Diabetic retinopathy graded by the modified Davis classification: 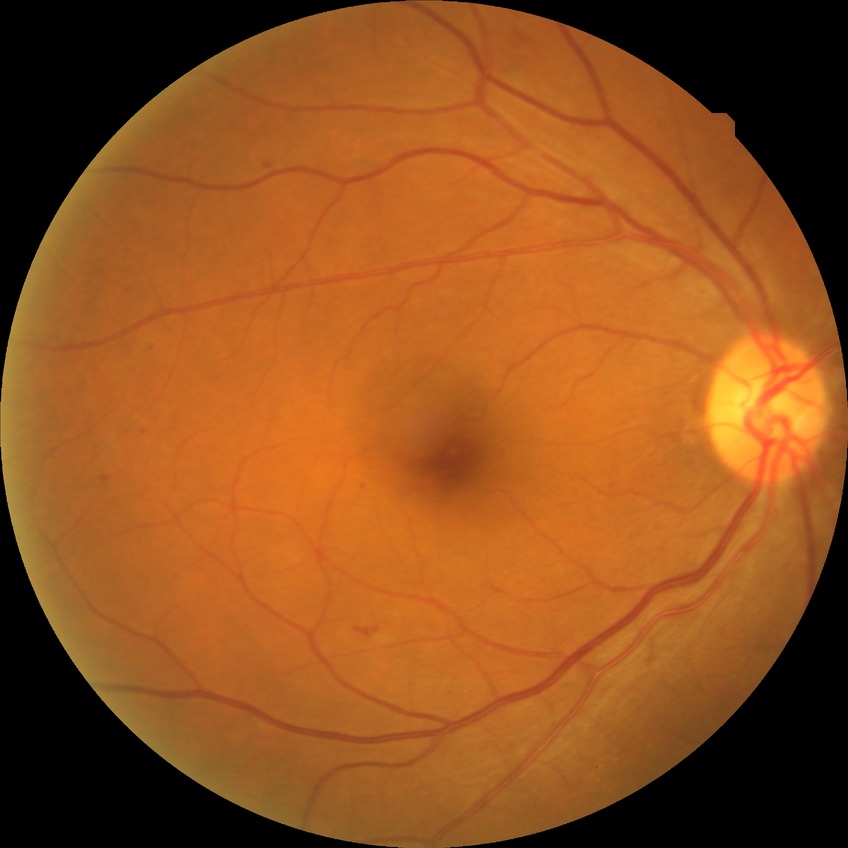 Findings:
• DR class: non-proliferative diabetic retinopathy
• diabetic retinopathy (DR): PPDR (pre-proliferative diabetic retinopathy)